1960 x 1897 pixels · 45° FOV · CFP: 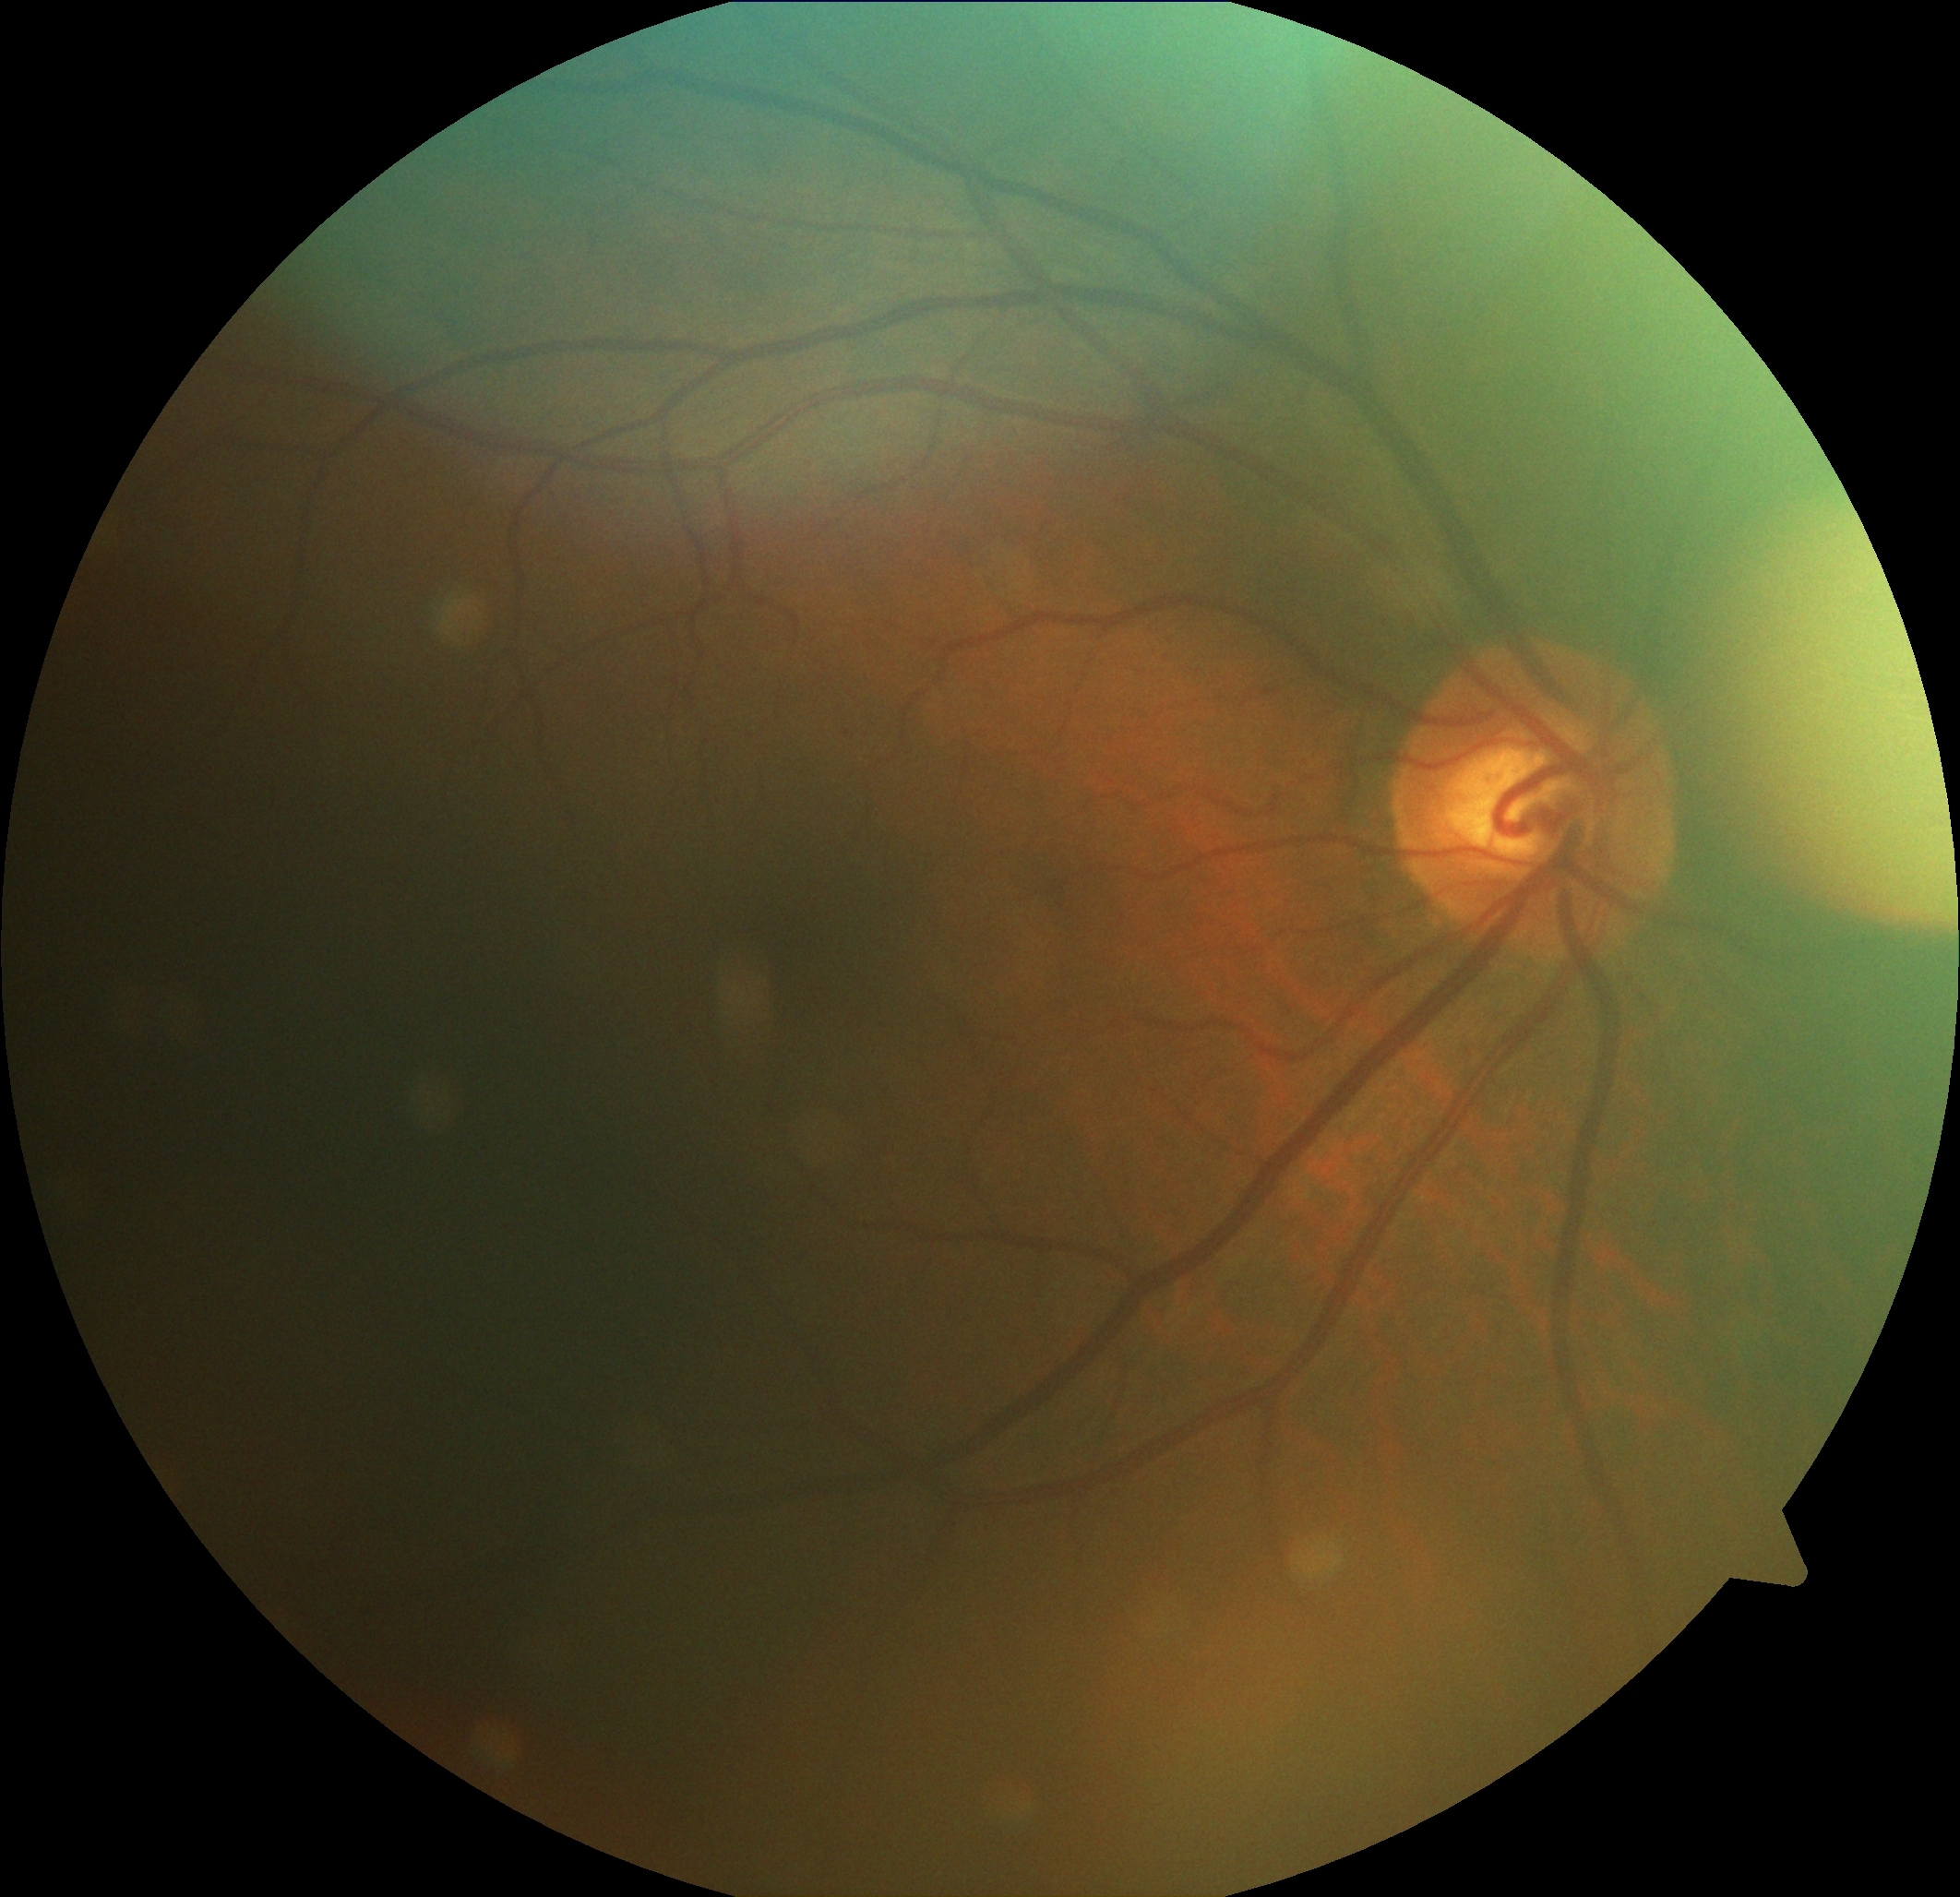

DR: no apparent retinopathy (grade 0). No DR findings.